Posterior pole photograph; nonmydriatic:
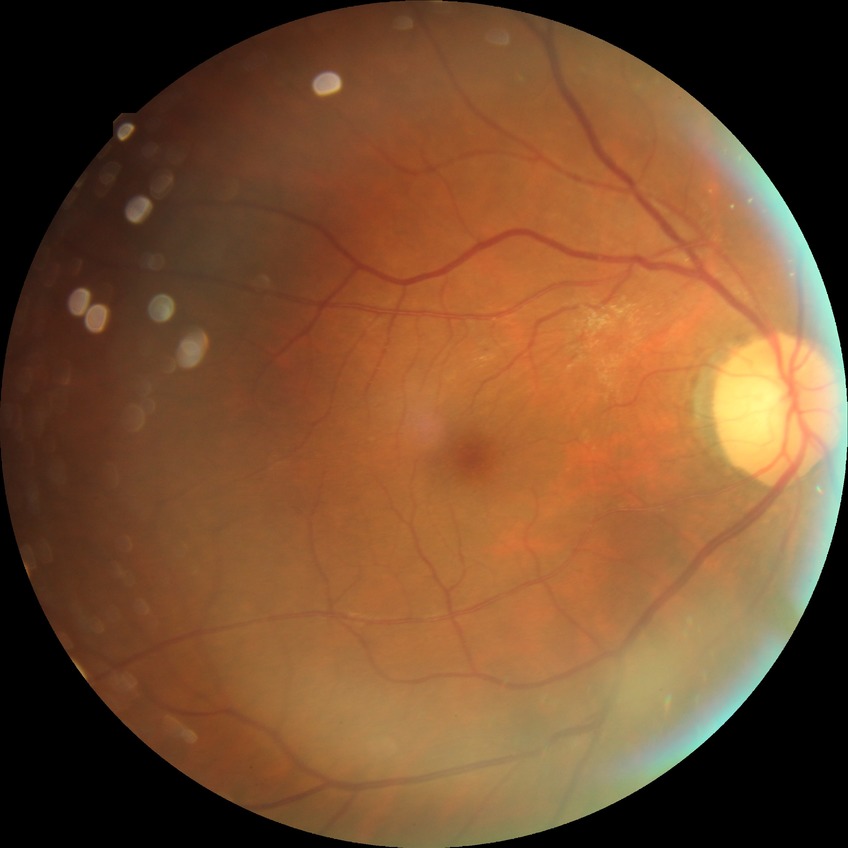
retinopathy stage@no diabetic retinopathy.